Wide-field fundus photograph of an infant · image size 640x480
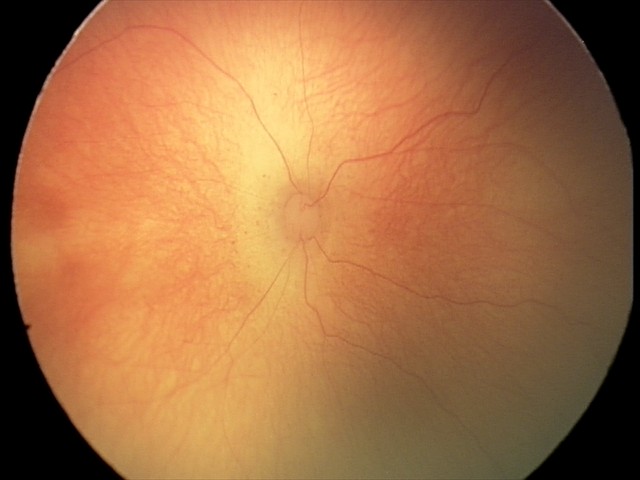 Diagnosis from this screening exam: retinopathy of prematurity stage 1.